Wide-field fundus photograph from neonatal ROP screening · image size 640x480 — 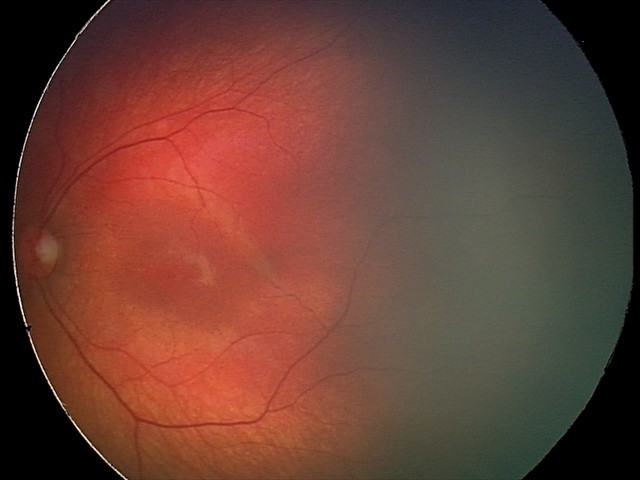

From an examination with diagnosis of retinal hemorrhages.